1659x2212. Color fundus image. Remidio Fundus on Phone — 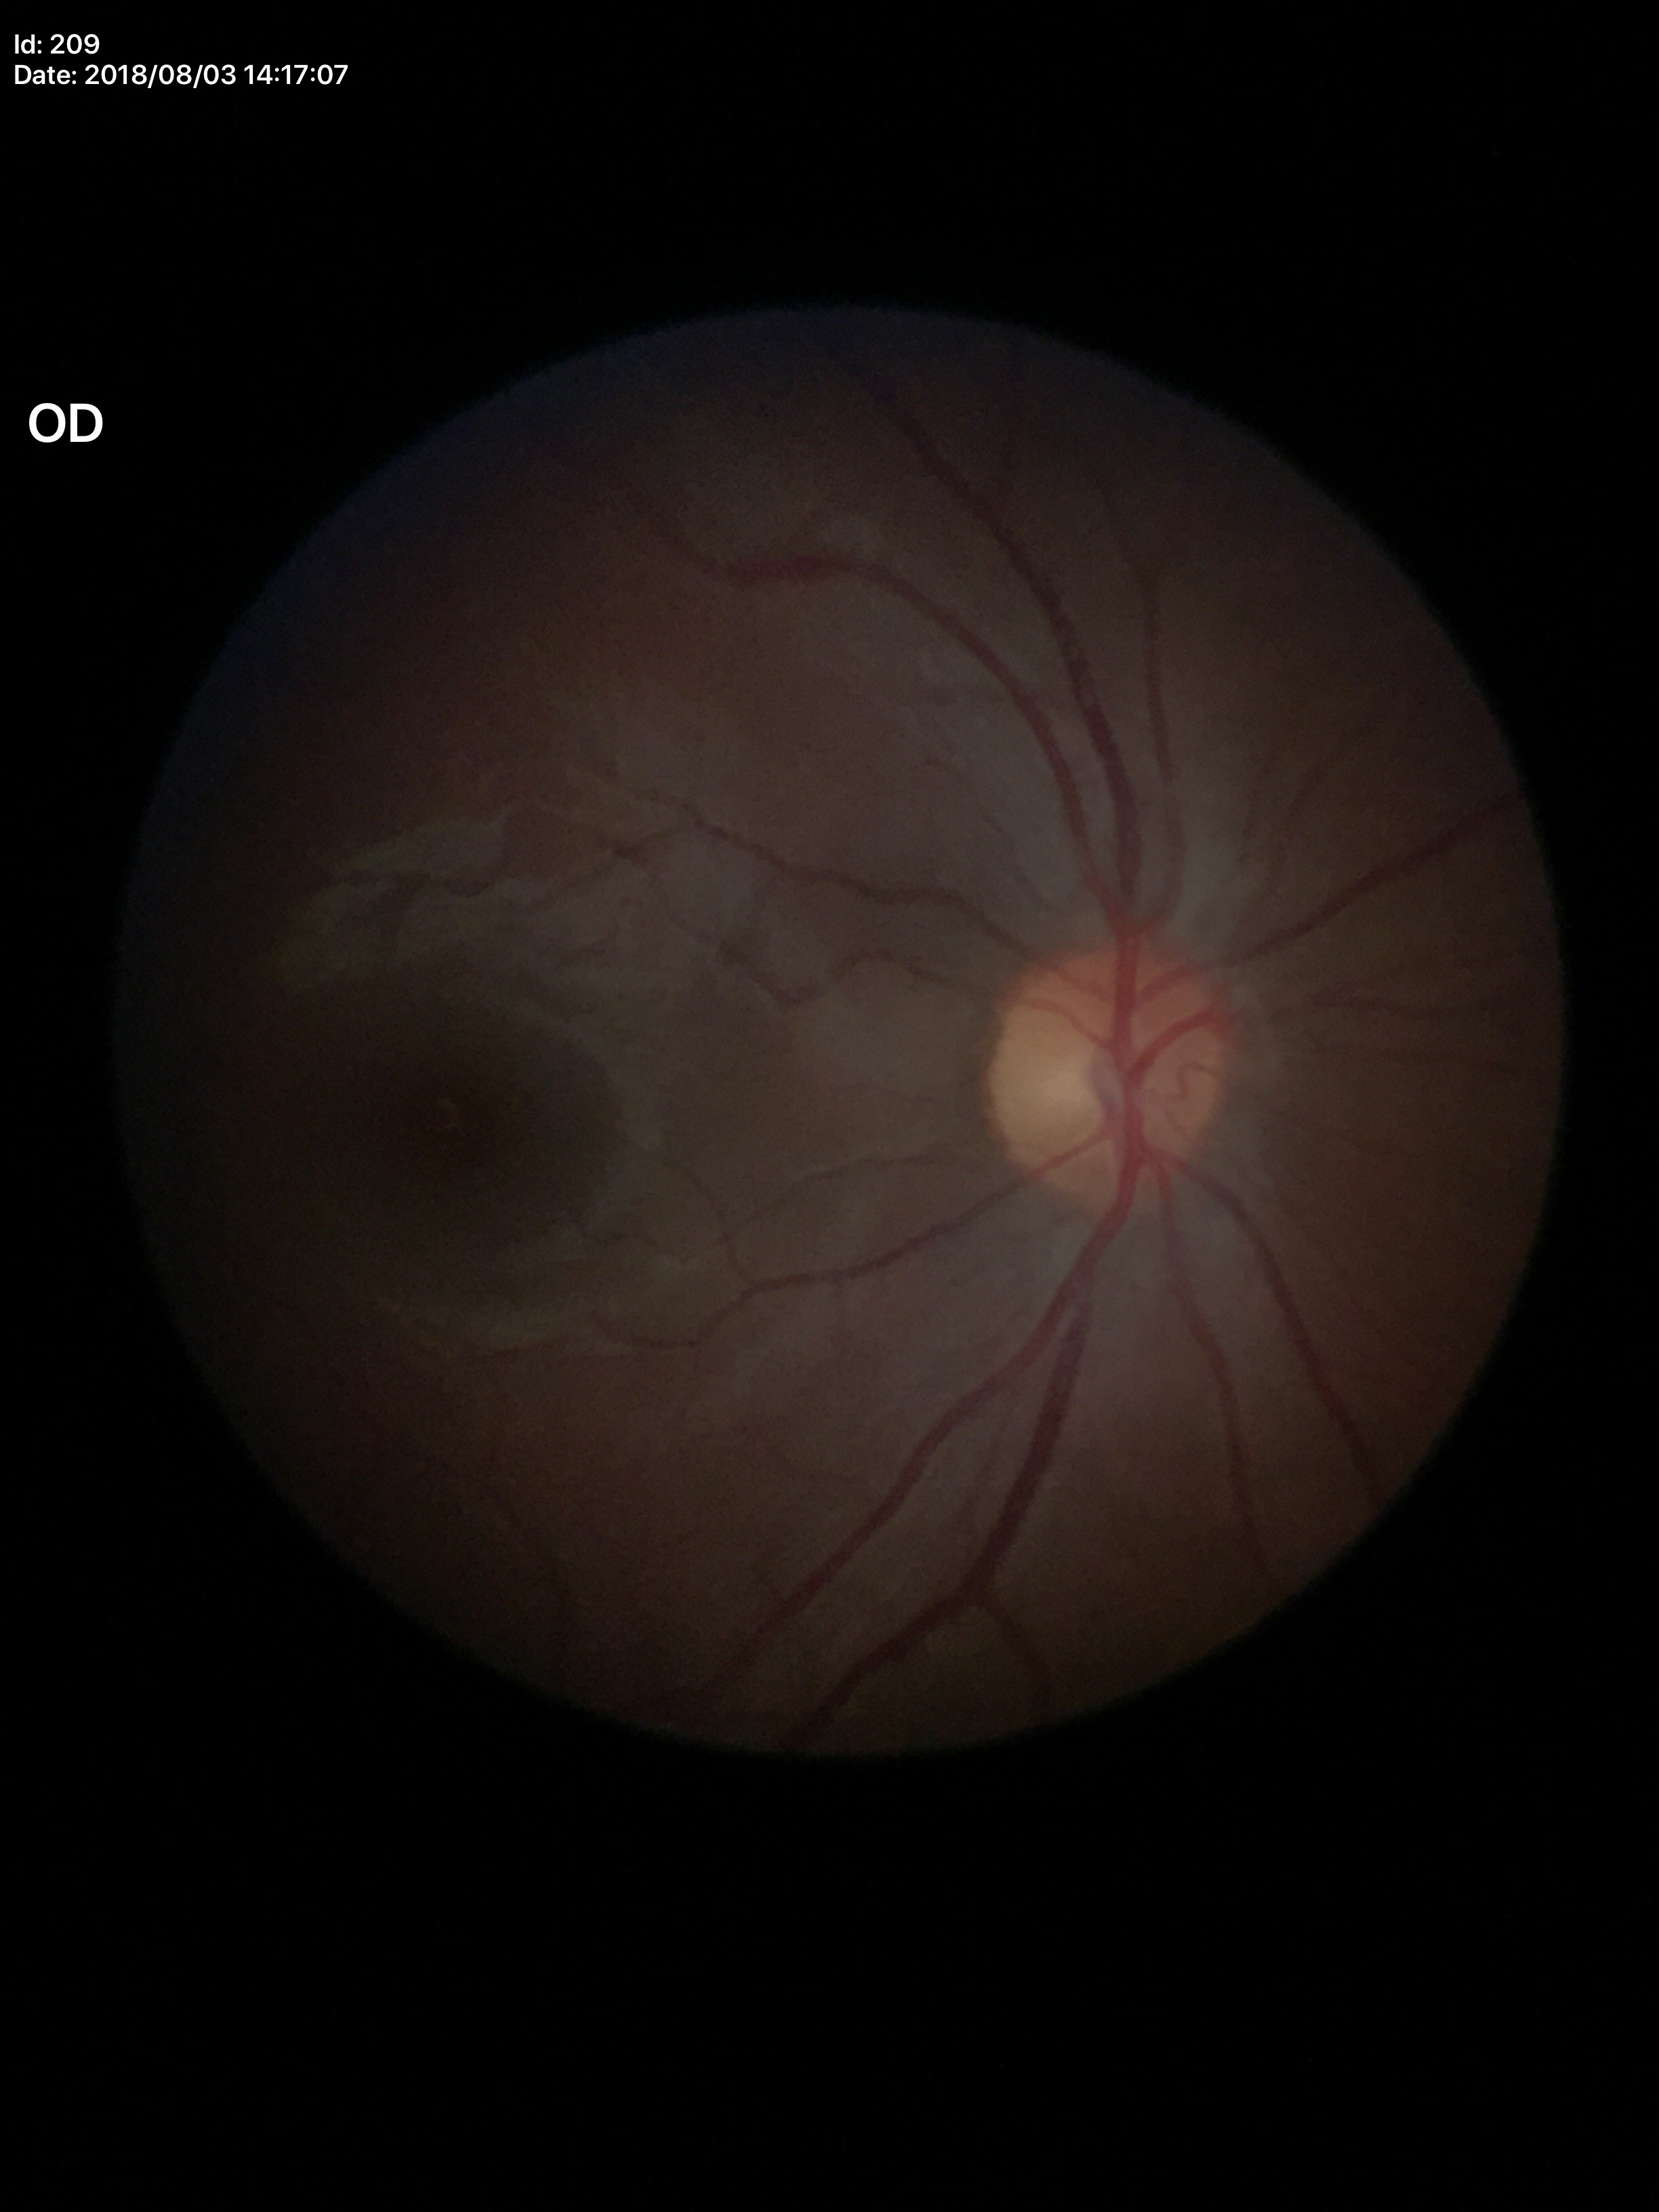

HCDR is 0.41. Not suspicious for glaucoma (all 5 graders called normal). VCDR of 0.42.